CFP; 1659x2212
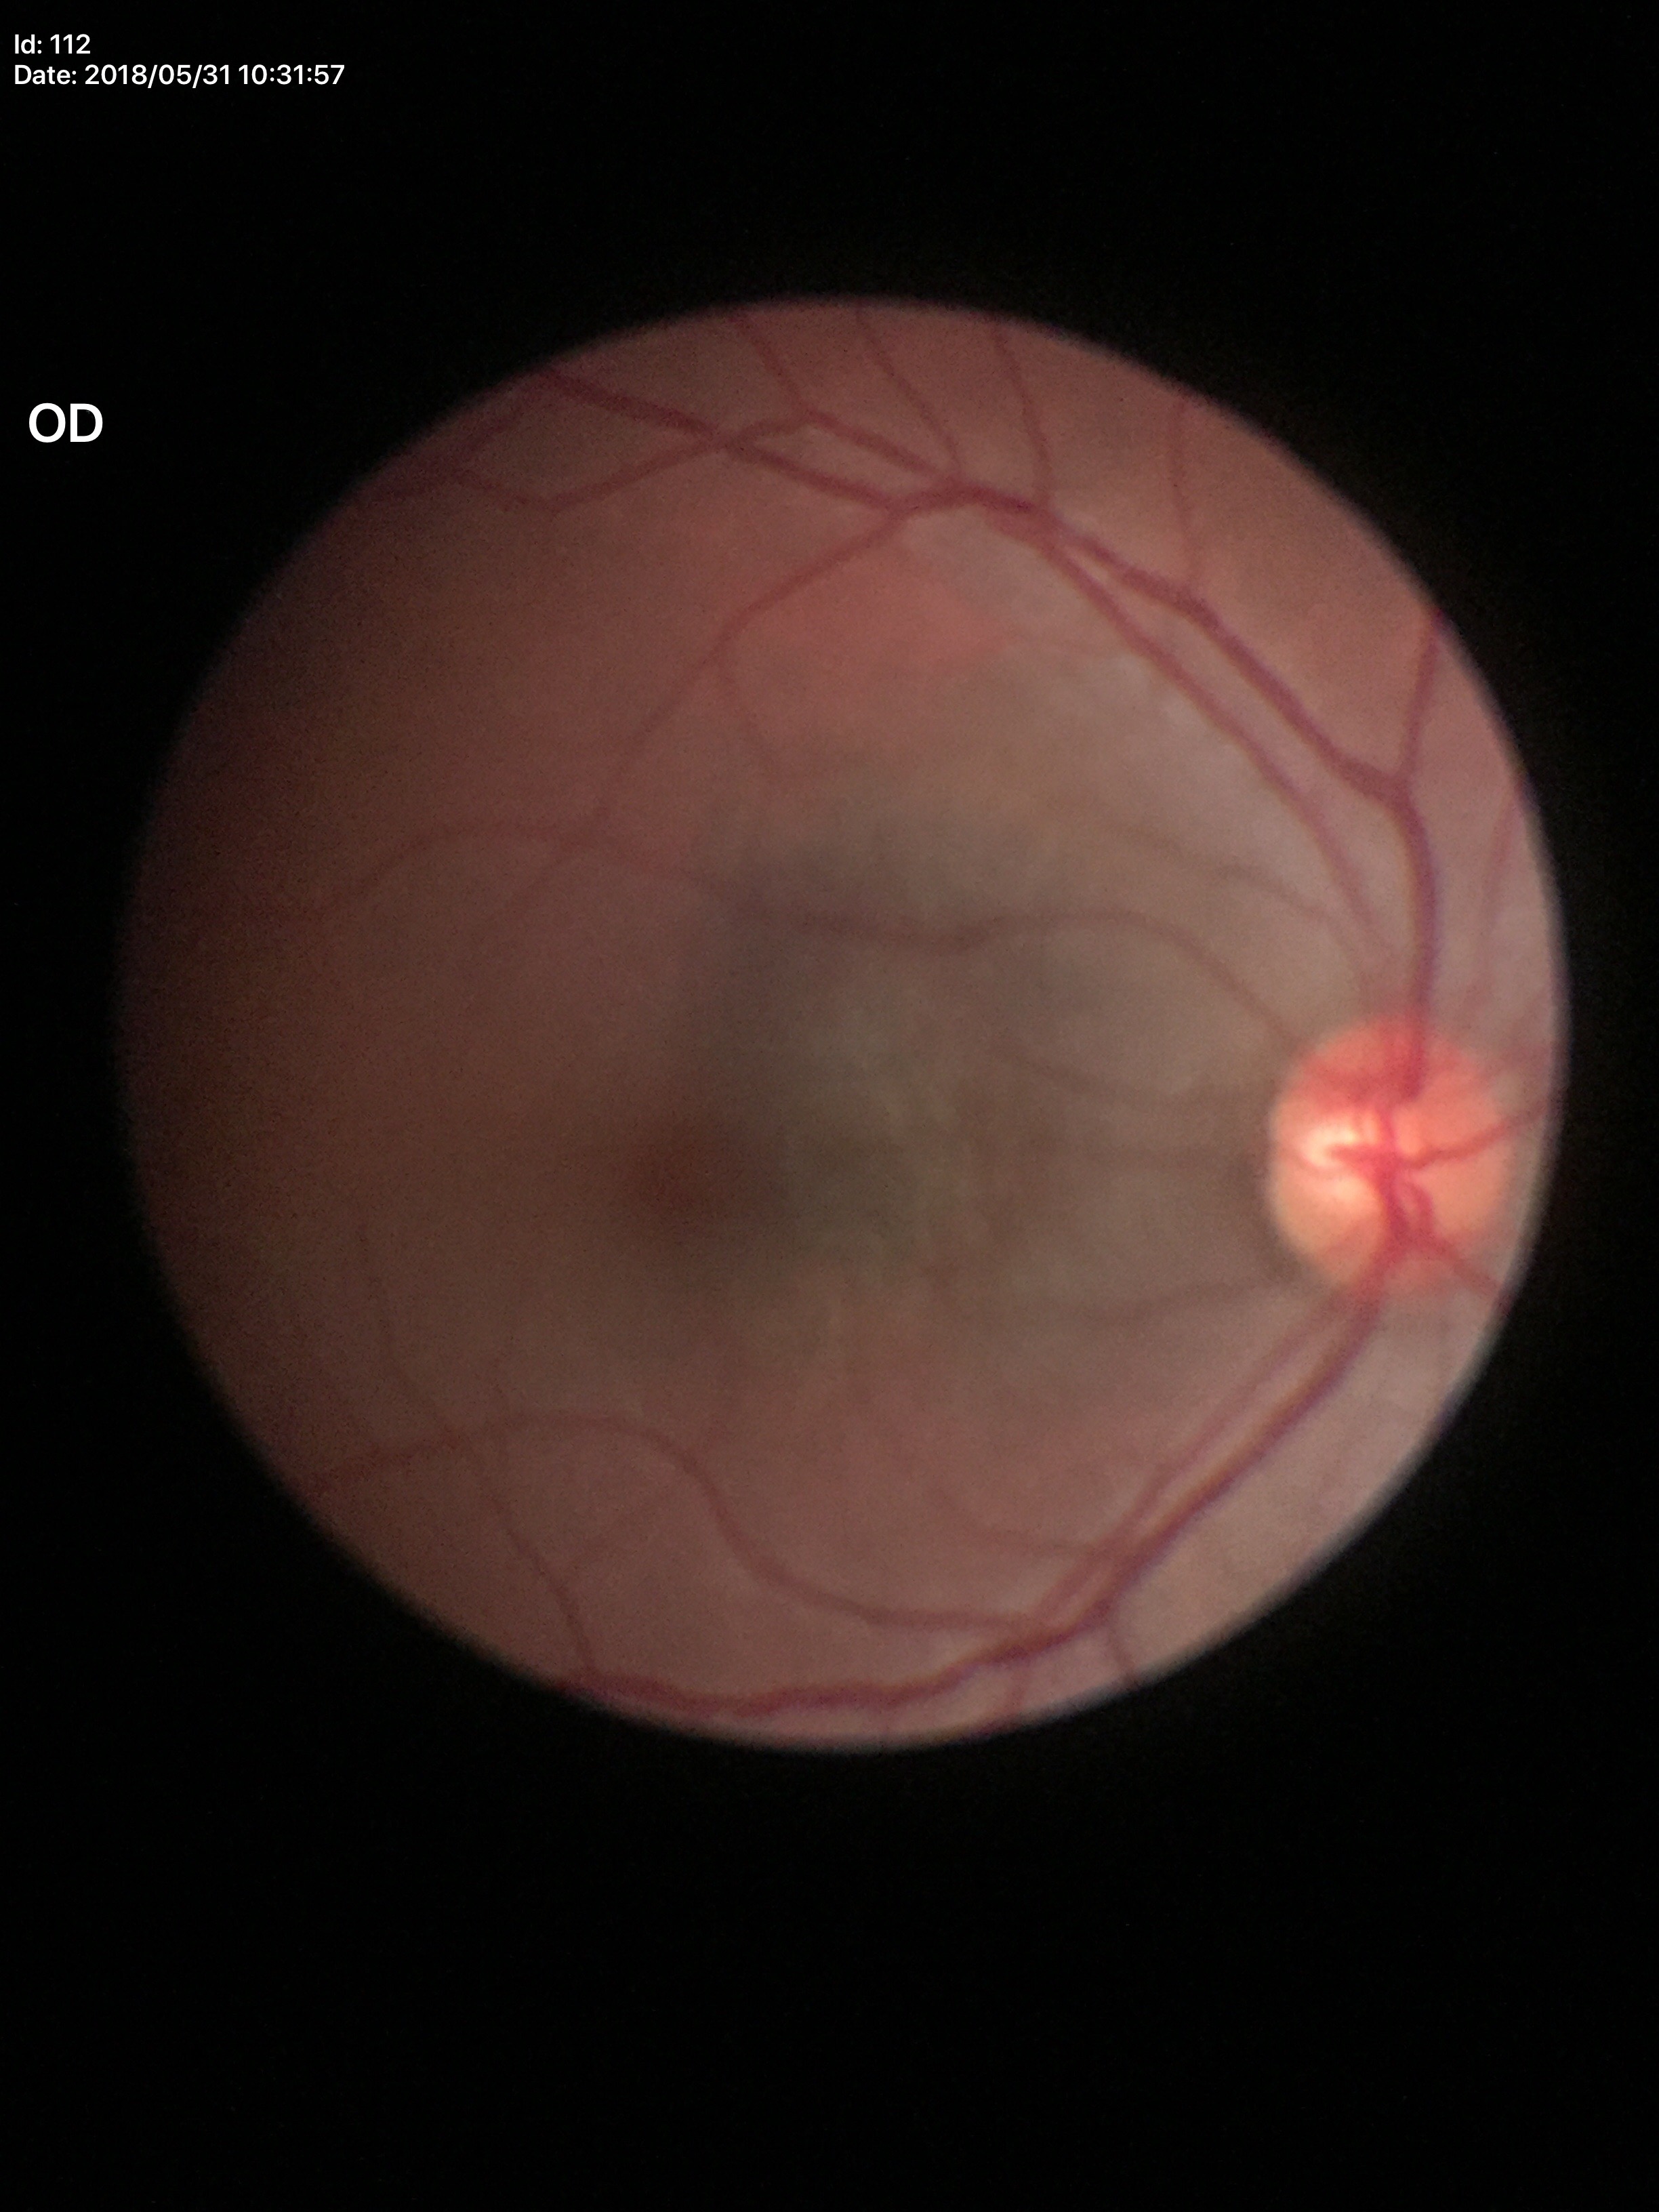 Glaucoma evaluation = not suspect
vertical cup-to-disc ratio = 0.49
horizontal cup-to-disc ratio = 0.56